45-degree field of view — 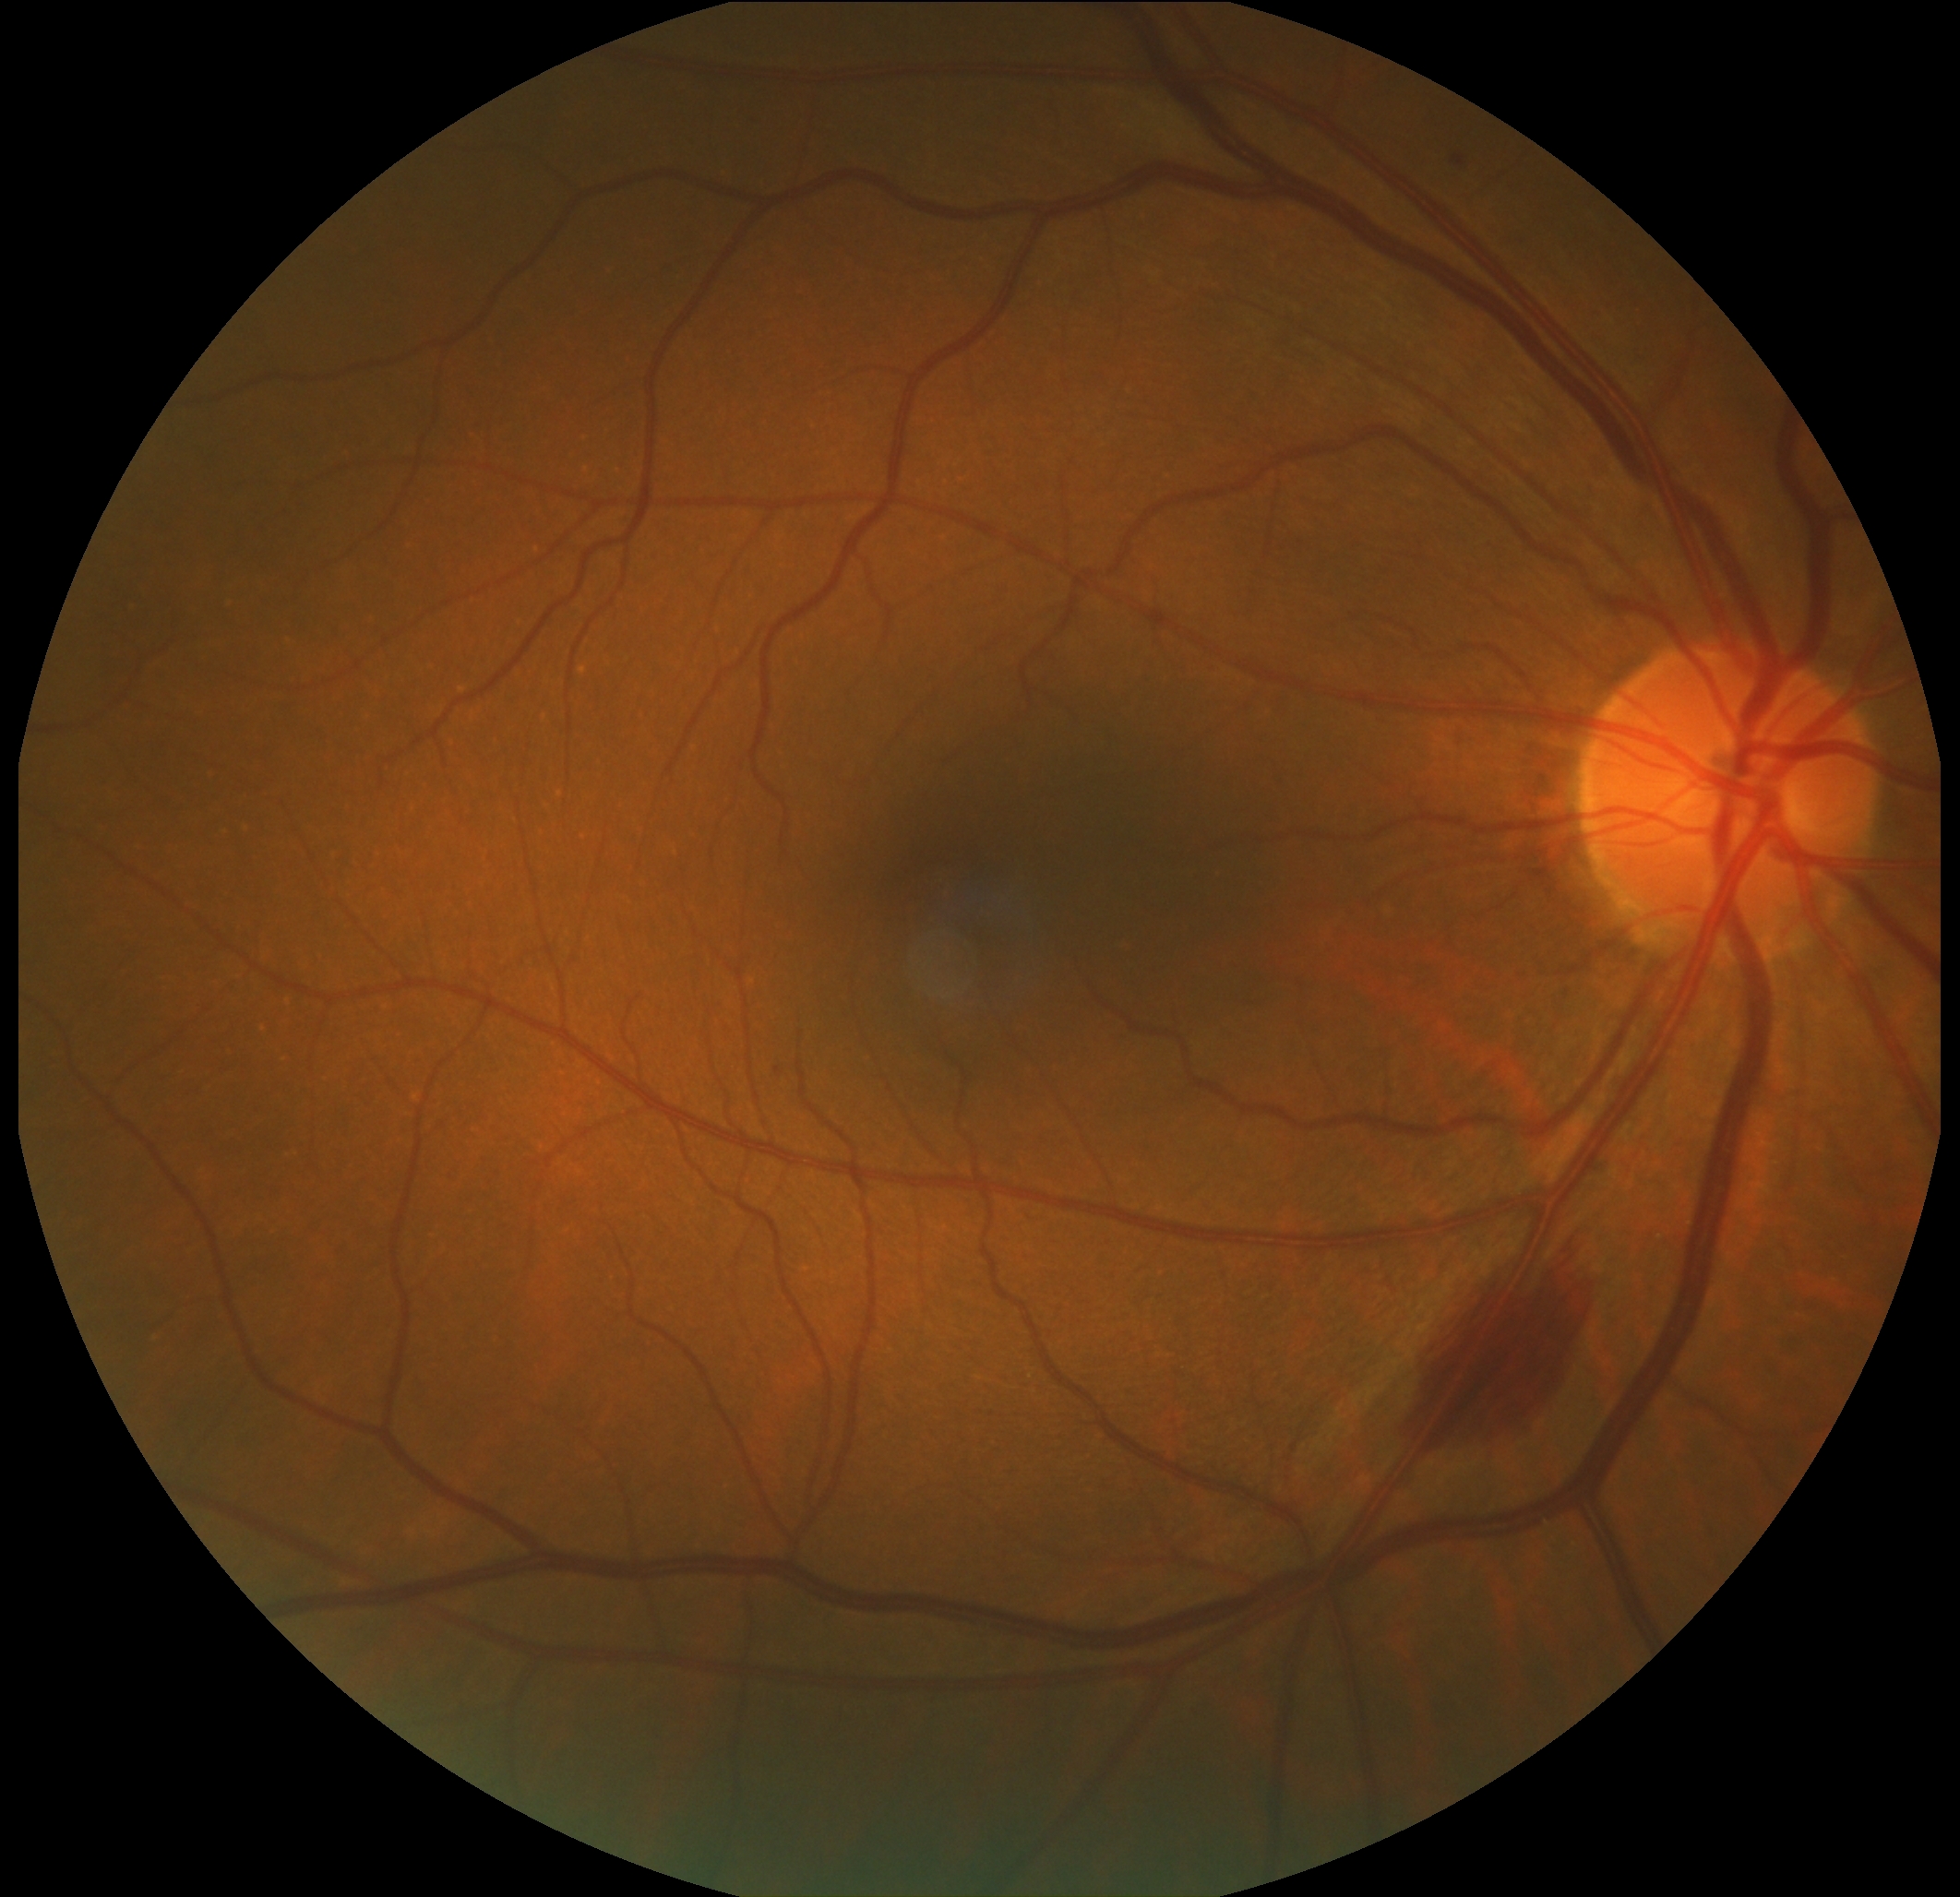
{"dr_grade": "2 — more than just microaneurysms but less than severe NPDR"}